Without pupil dilation, NIDEK AFC-230 fundus camera.
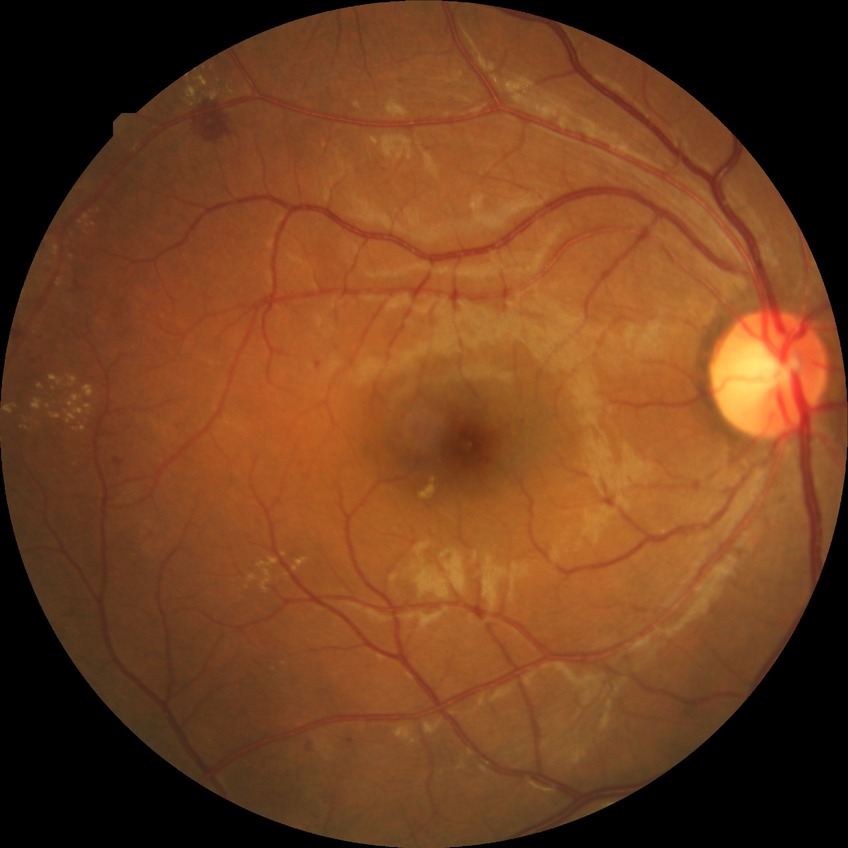

Davis DR grade = SDR; DR class = non-proliferative diabetic retinopathy.